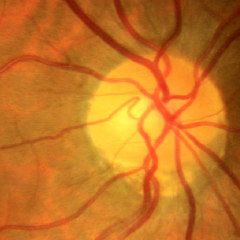 There is evidence of no glaucomatous findings.